Camera: Remidio Fundus on Phone (FOP) camera
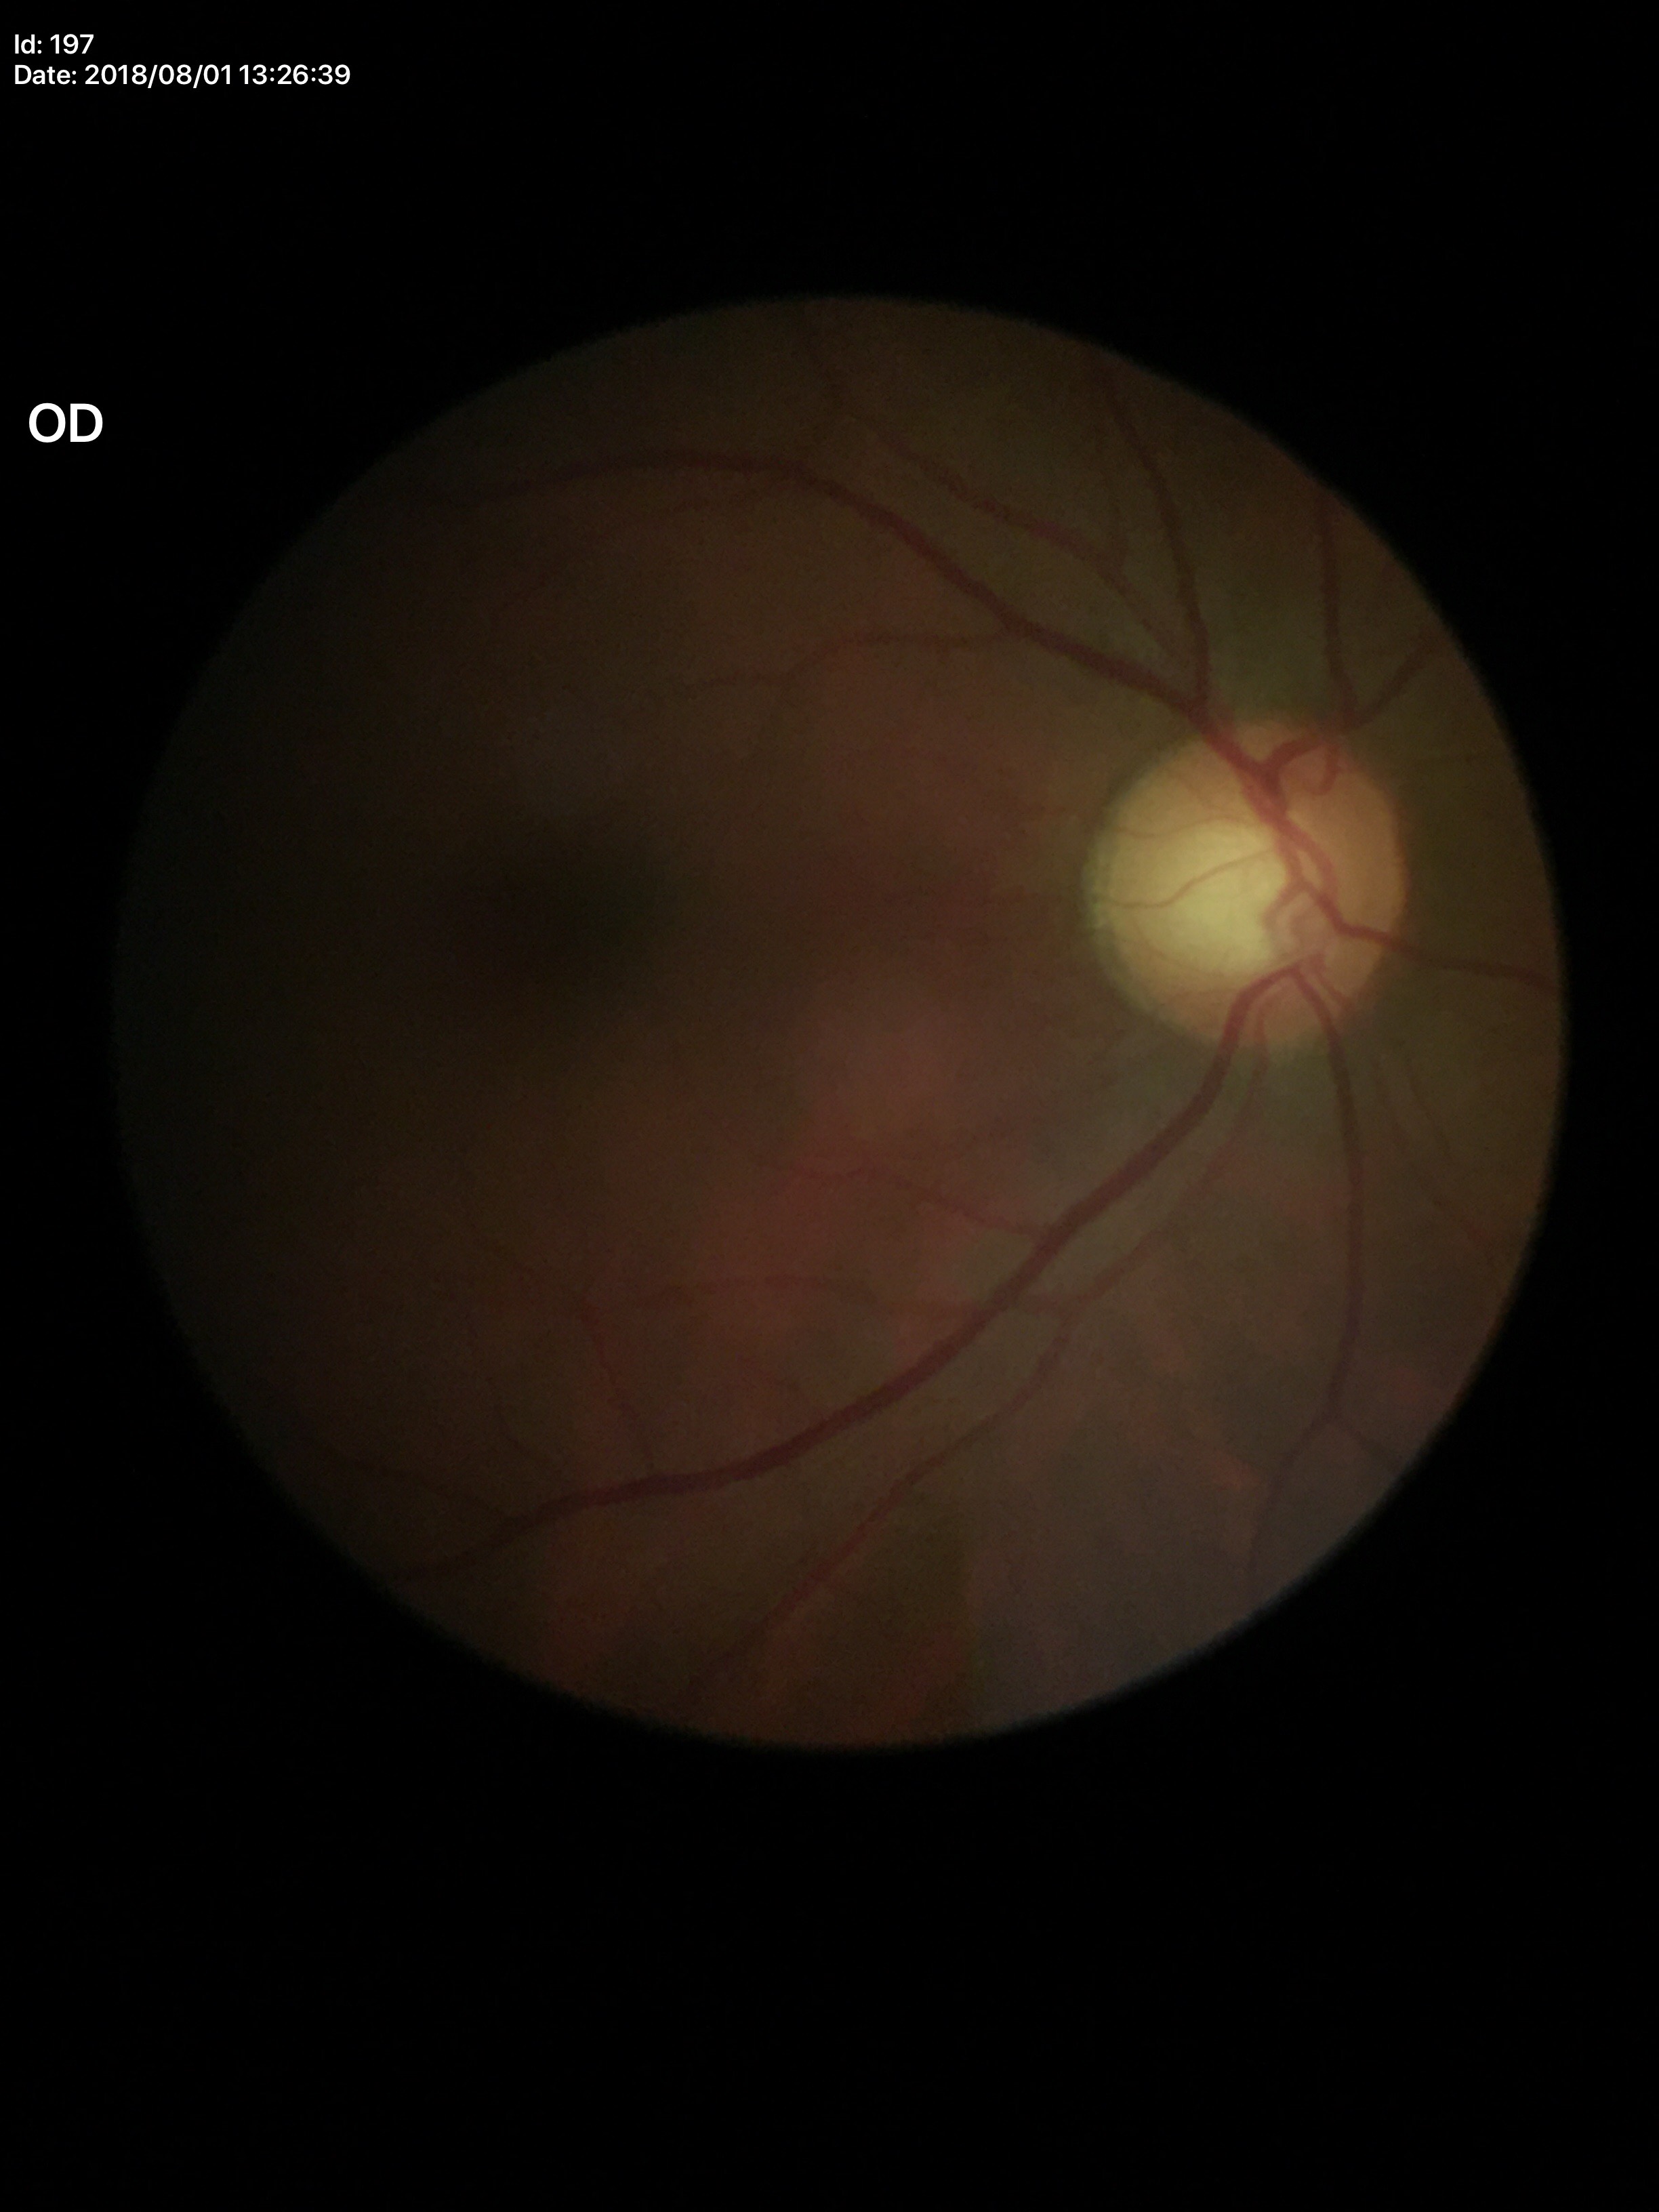
Annotations:
* Glaucoma impression: suspect
* VCDR: 0.60